Acquired with a NIDEK AFC-230. 848x848px:
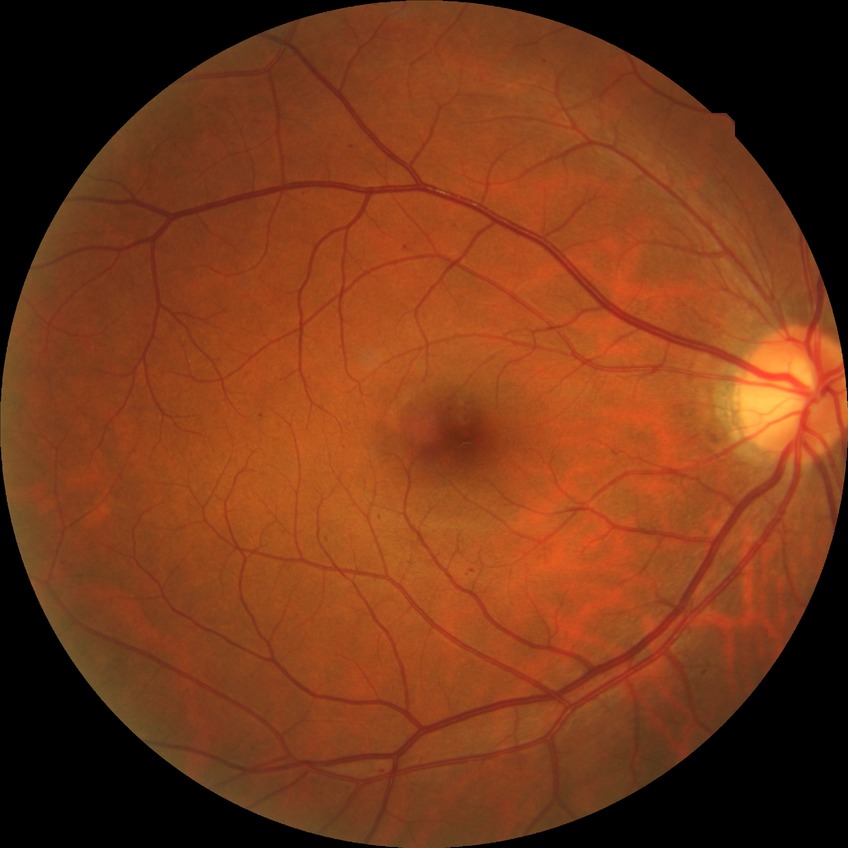

Diabetic retinopathy (DR) is SDR (simple diabetic retinopathy).